848 x 848 pixels; modified Davis grading
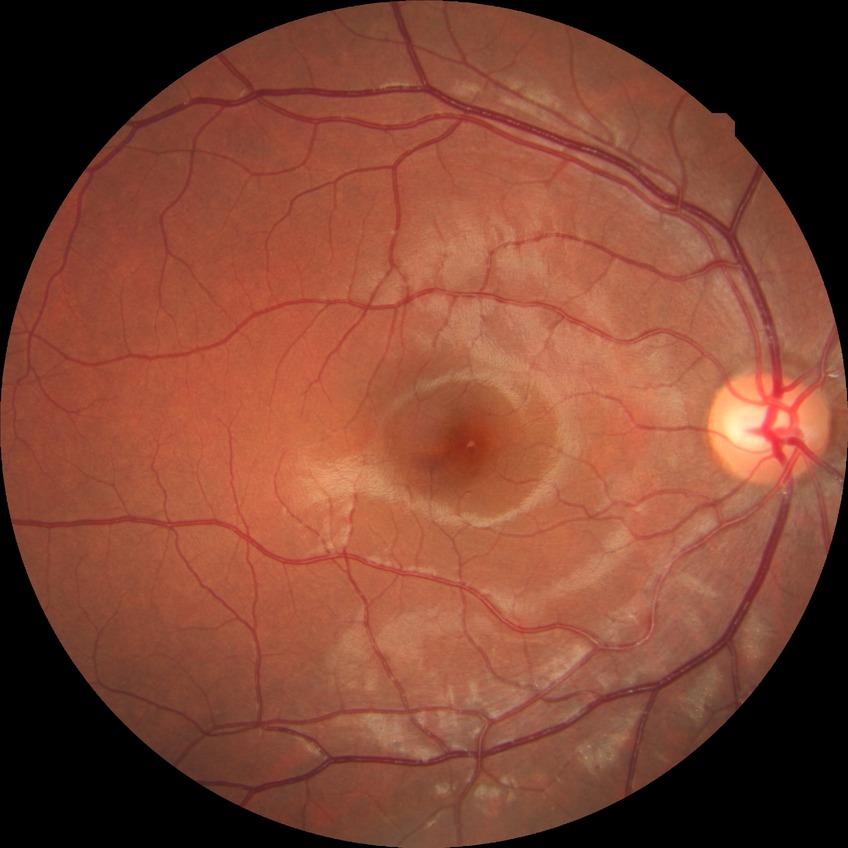 Diabetic retinopathy (DR): NDR (no diabetic retinopathy).